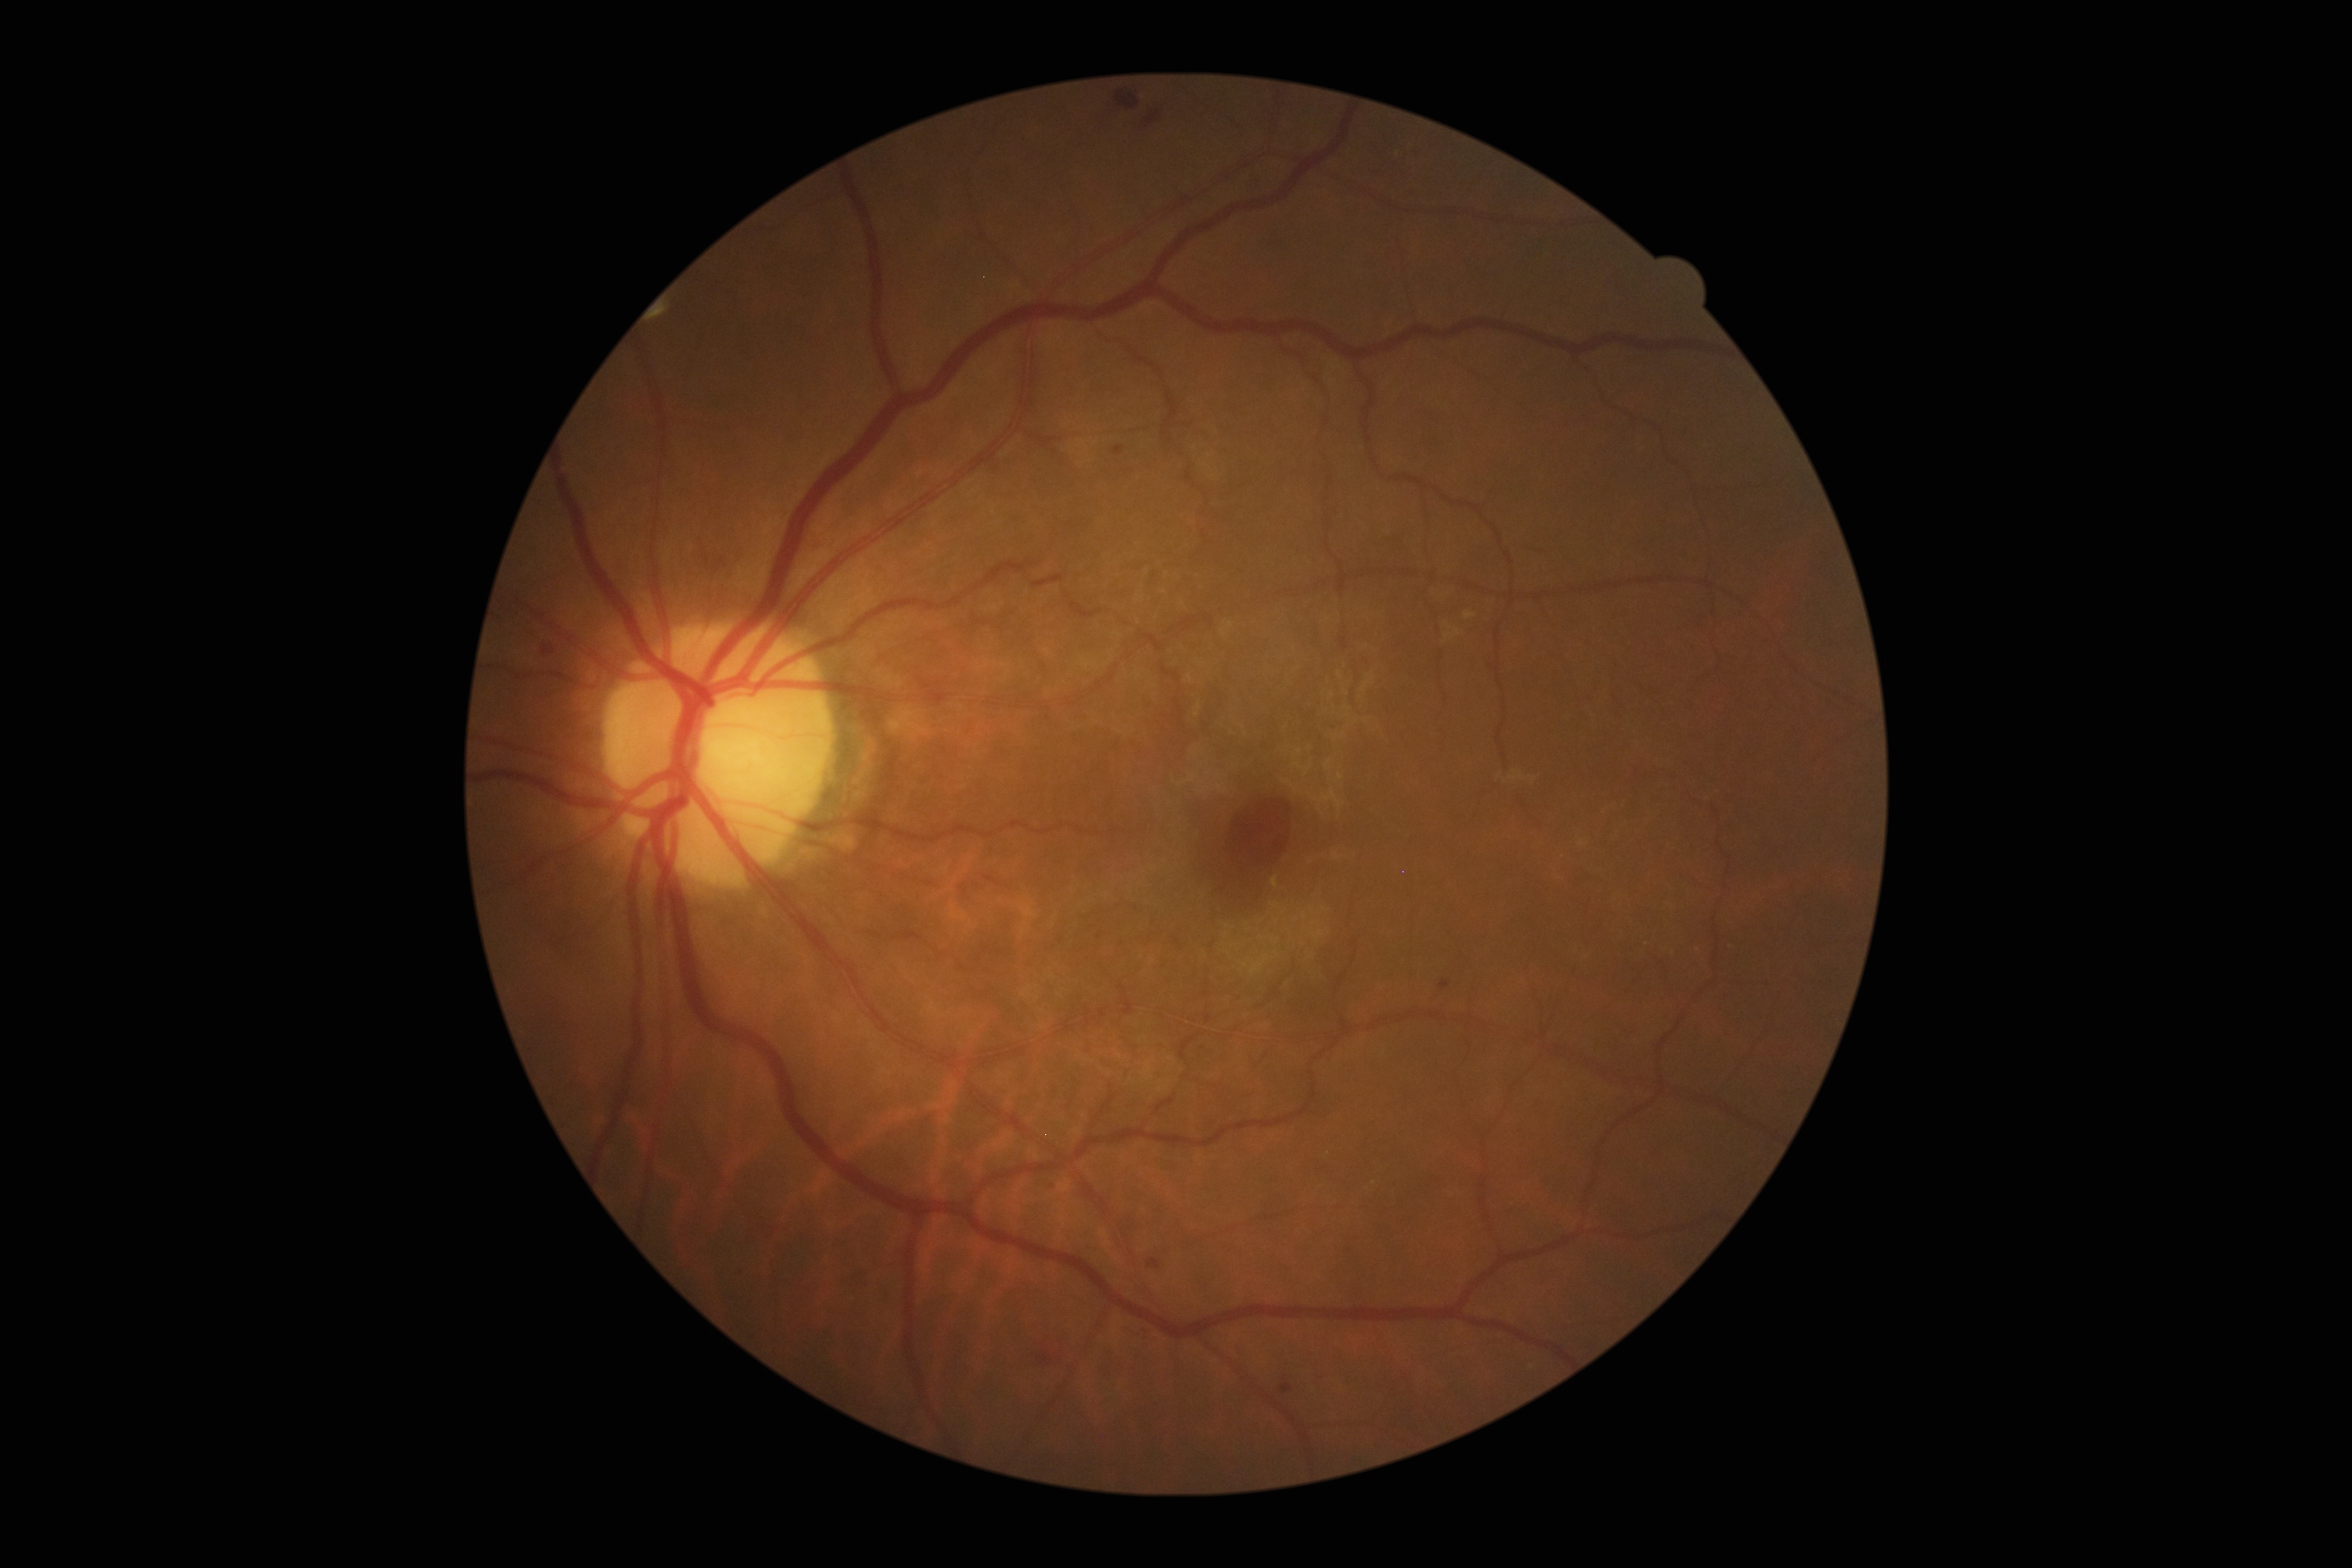 DR: moderate non-proliferative diabetic retinopathy (grade 2).